Diabetic retinopathy graded by the modified Davis classification:
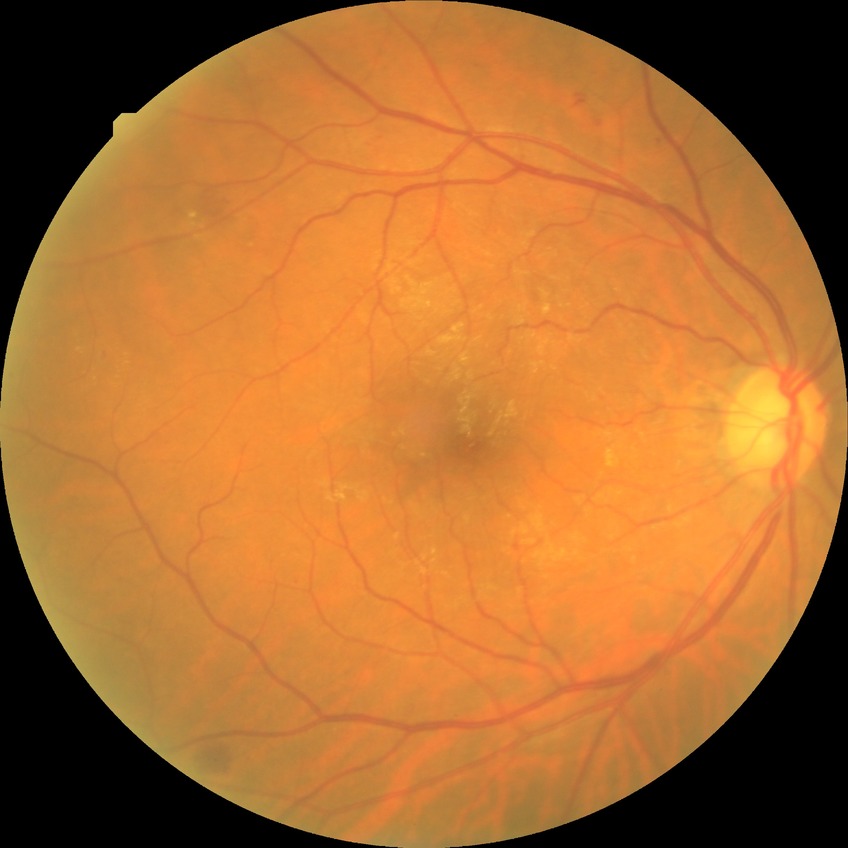
Annotations:
* DR class — non-proliferative diabetic retinopathy
* DR — SDR